1932x1910. Fundus photo. FOV: 45 degrees
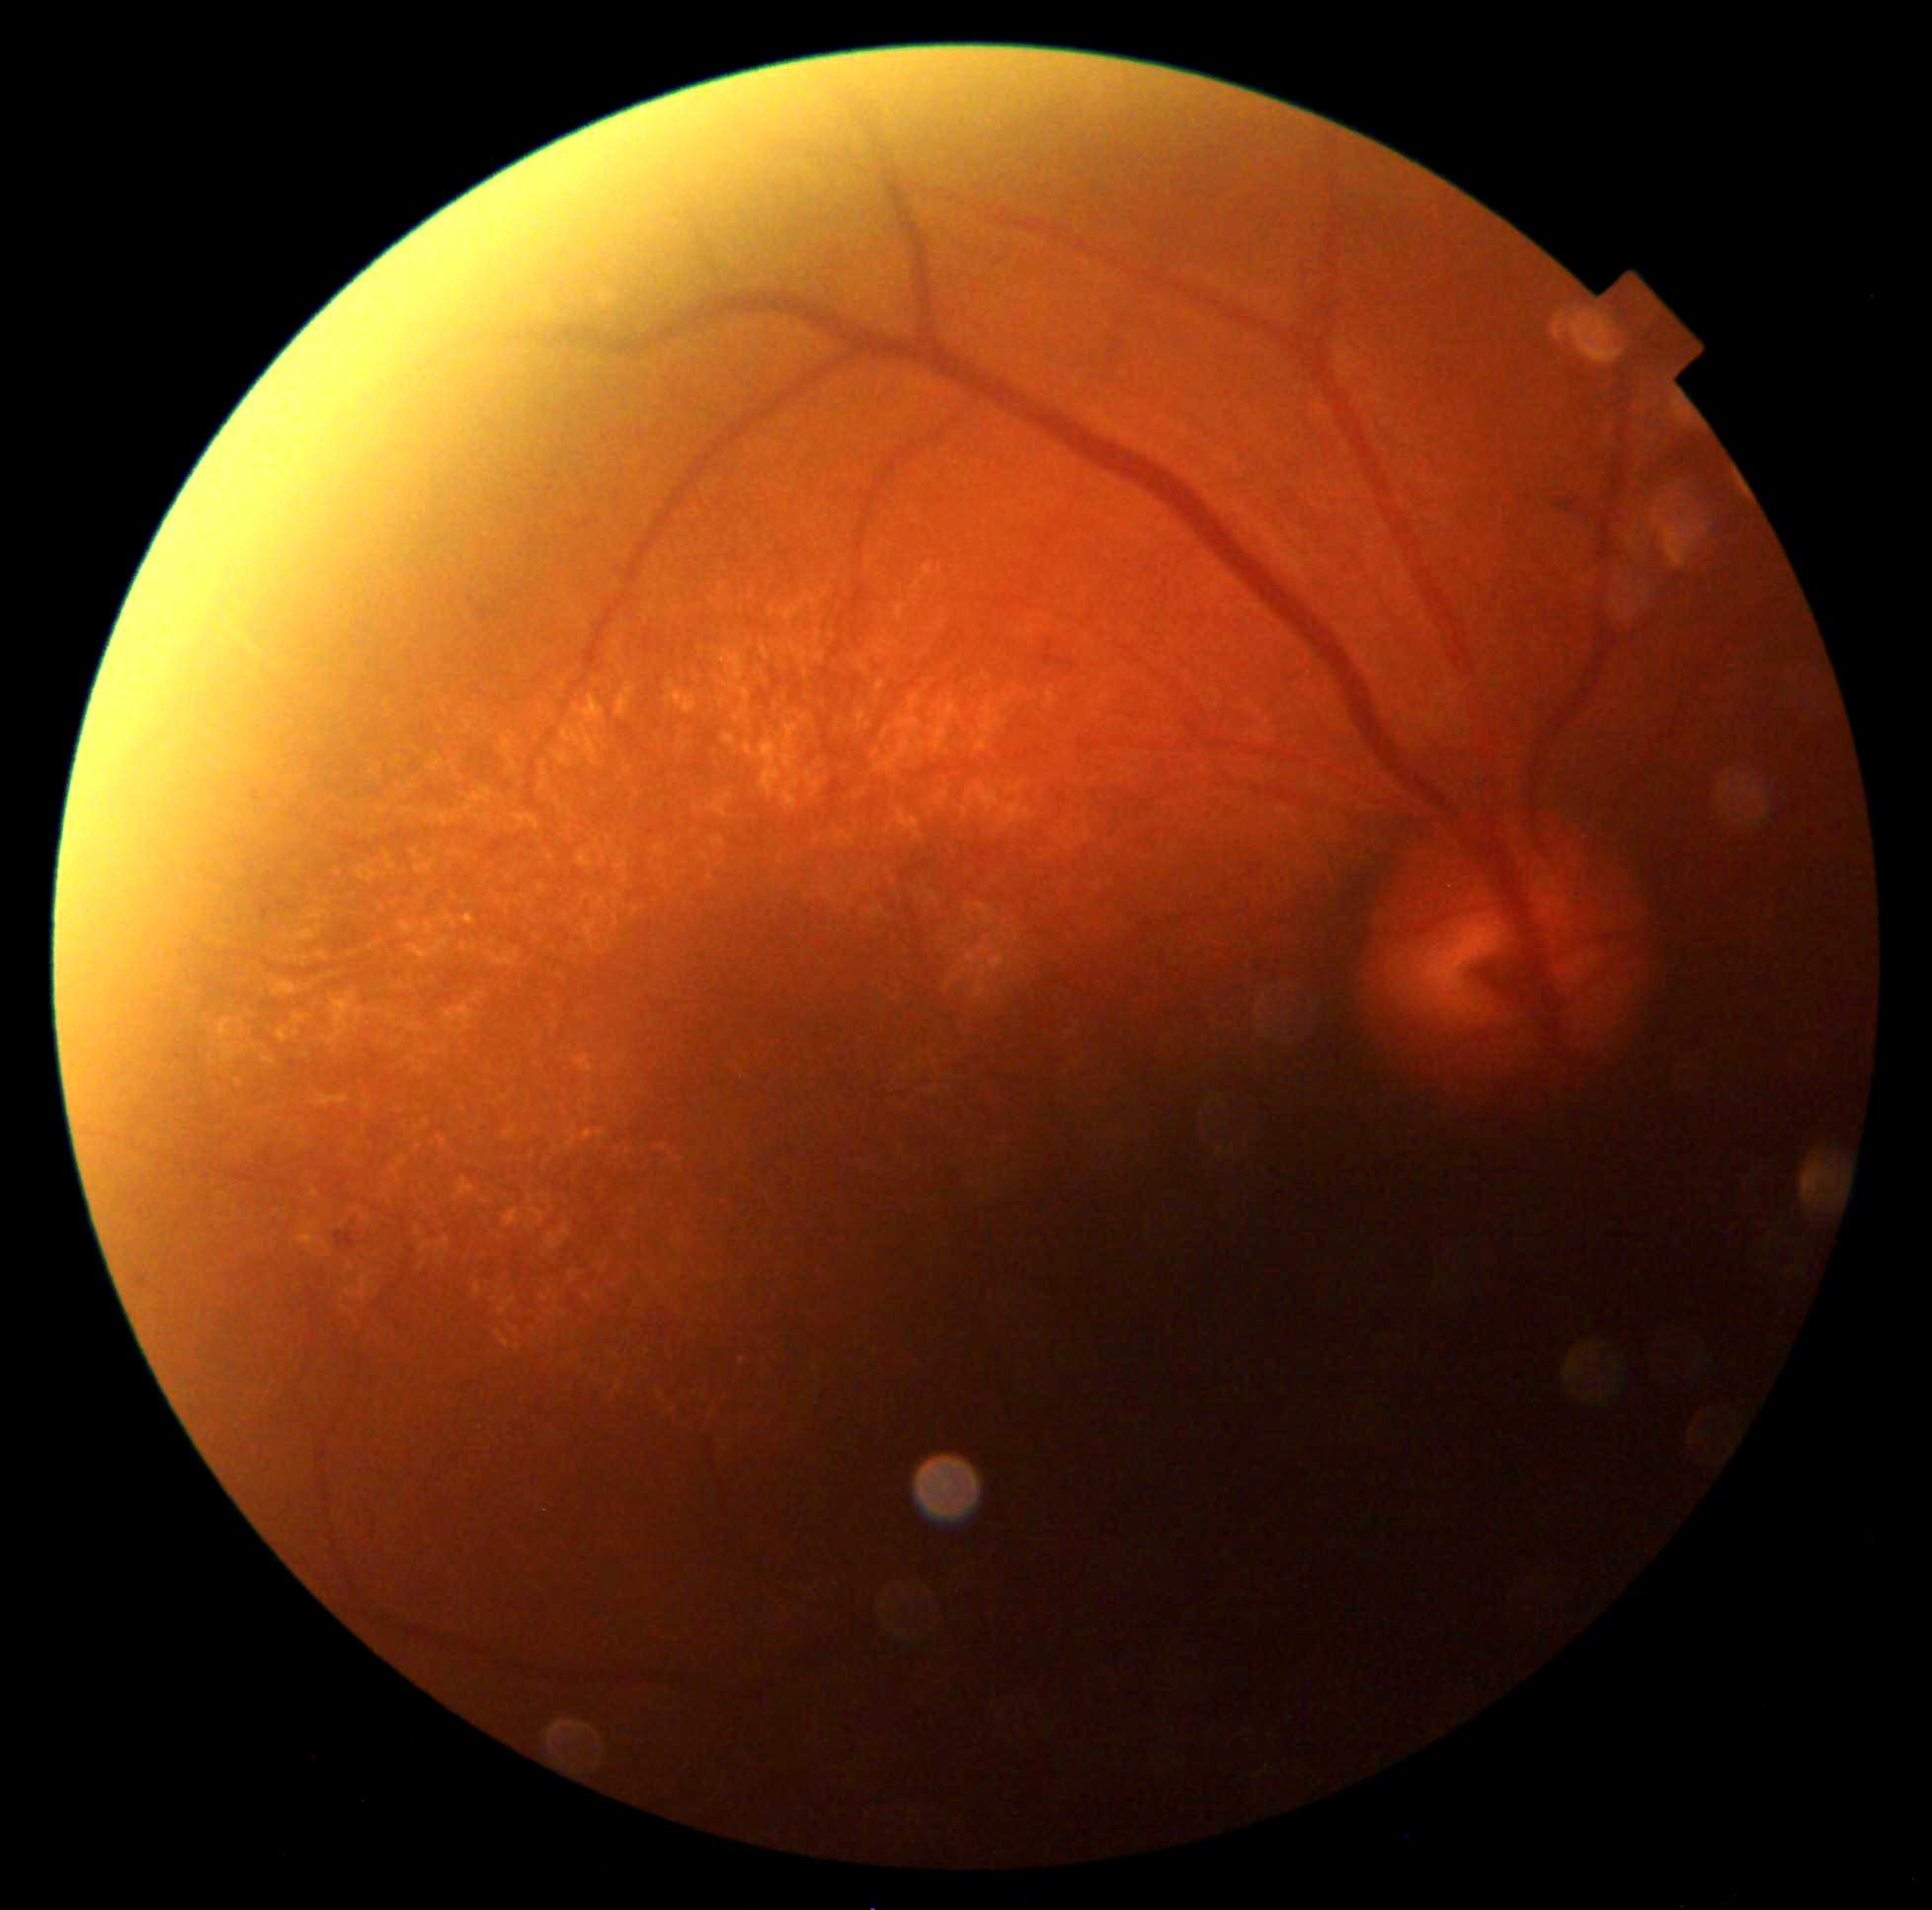
diabetic retinopathy (DR) = moderate NPDR (grade 2) | DR class = non-proliferative diabetic retinopathy.